Centered on the optic disc. Non-mydriatic acquisition. 240 x 240 pixels: 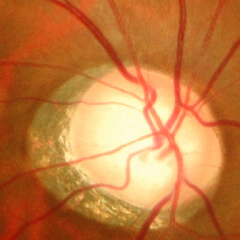
Q: Is glaucoma present?
A: Advanced glaucomatous optic neuropathy. Defined as near-total cupping of the optic nerve head, with or without severe visual field loss within the central 10 degrees of fixation.